Infant wide-field retinal image:
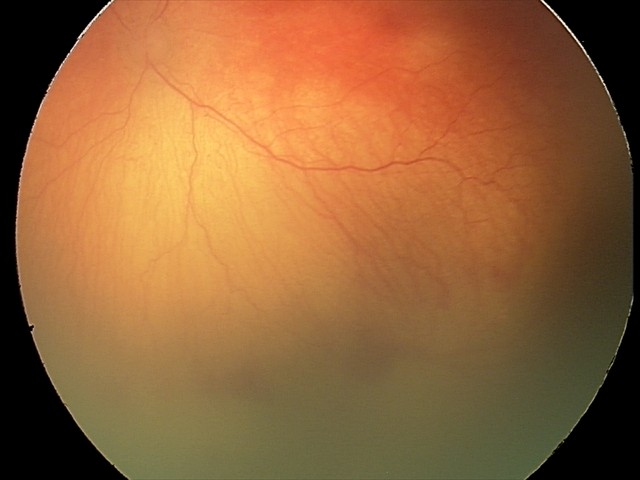 Diagnosis from this screening exam: aggressive ROP (A-ROP).